Infant wide-field retinal image · 100° field of view (Phoenix ICON) · 1240 by 1240 pixels:
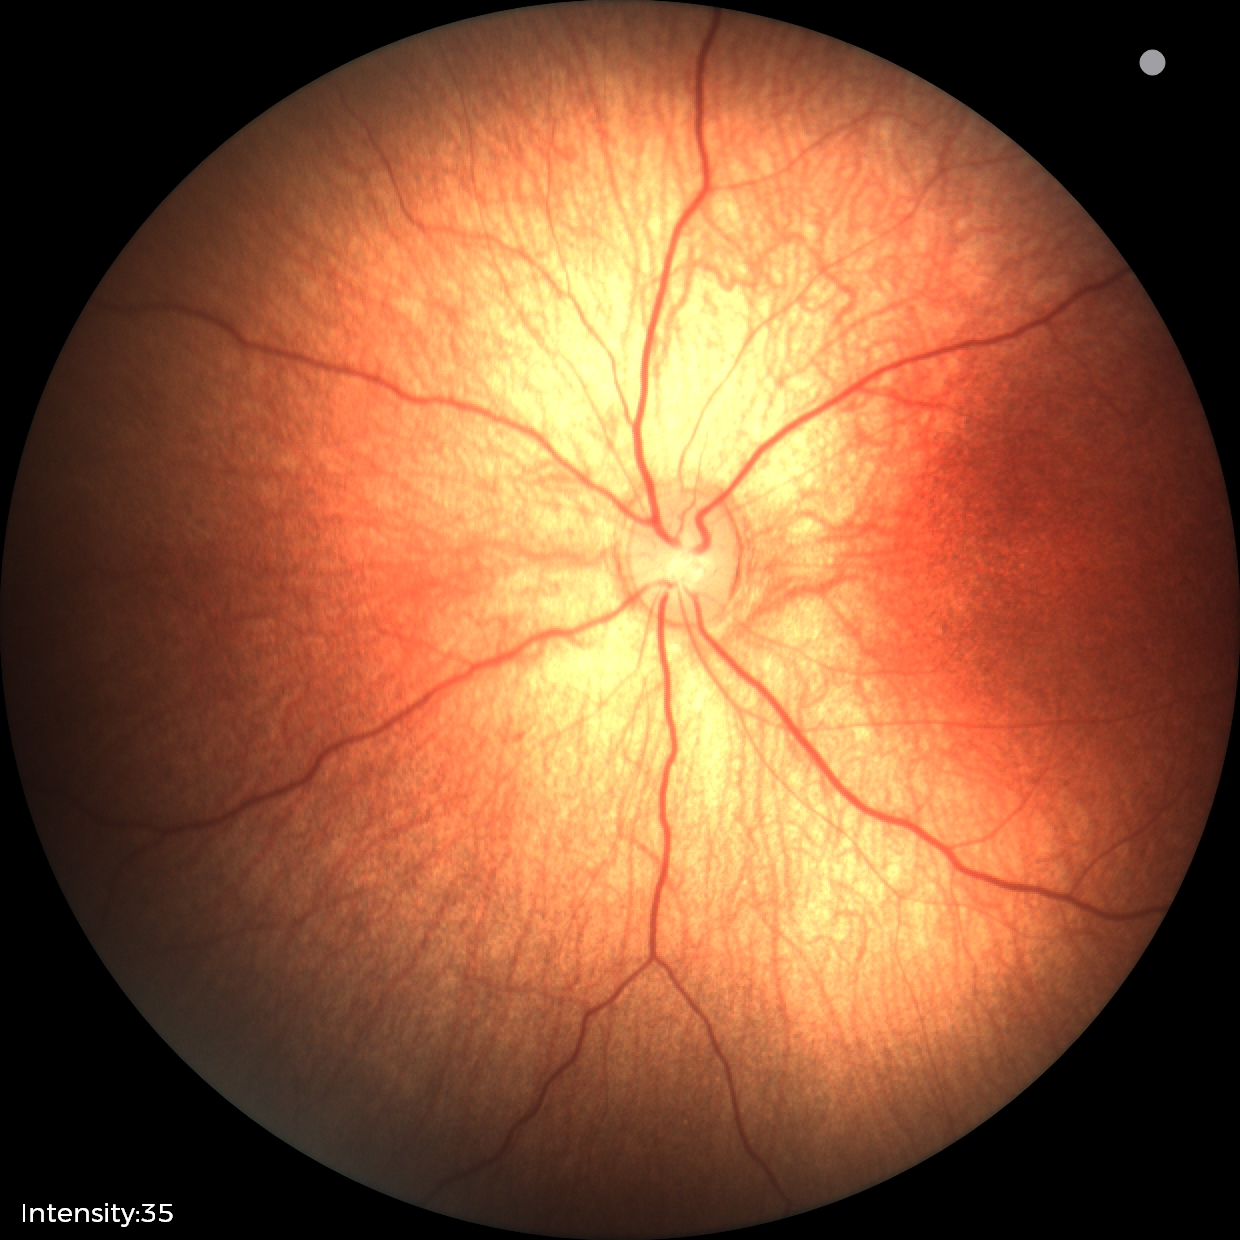

No retinal pathology identified on screening.